Image size 2352x1568 — 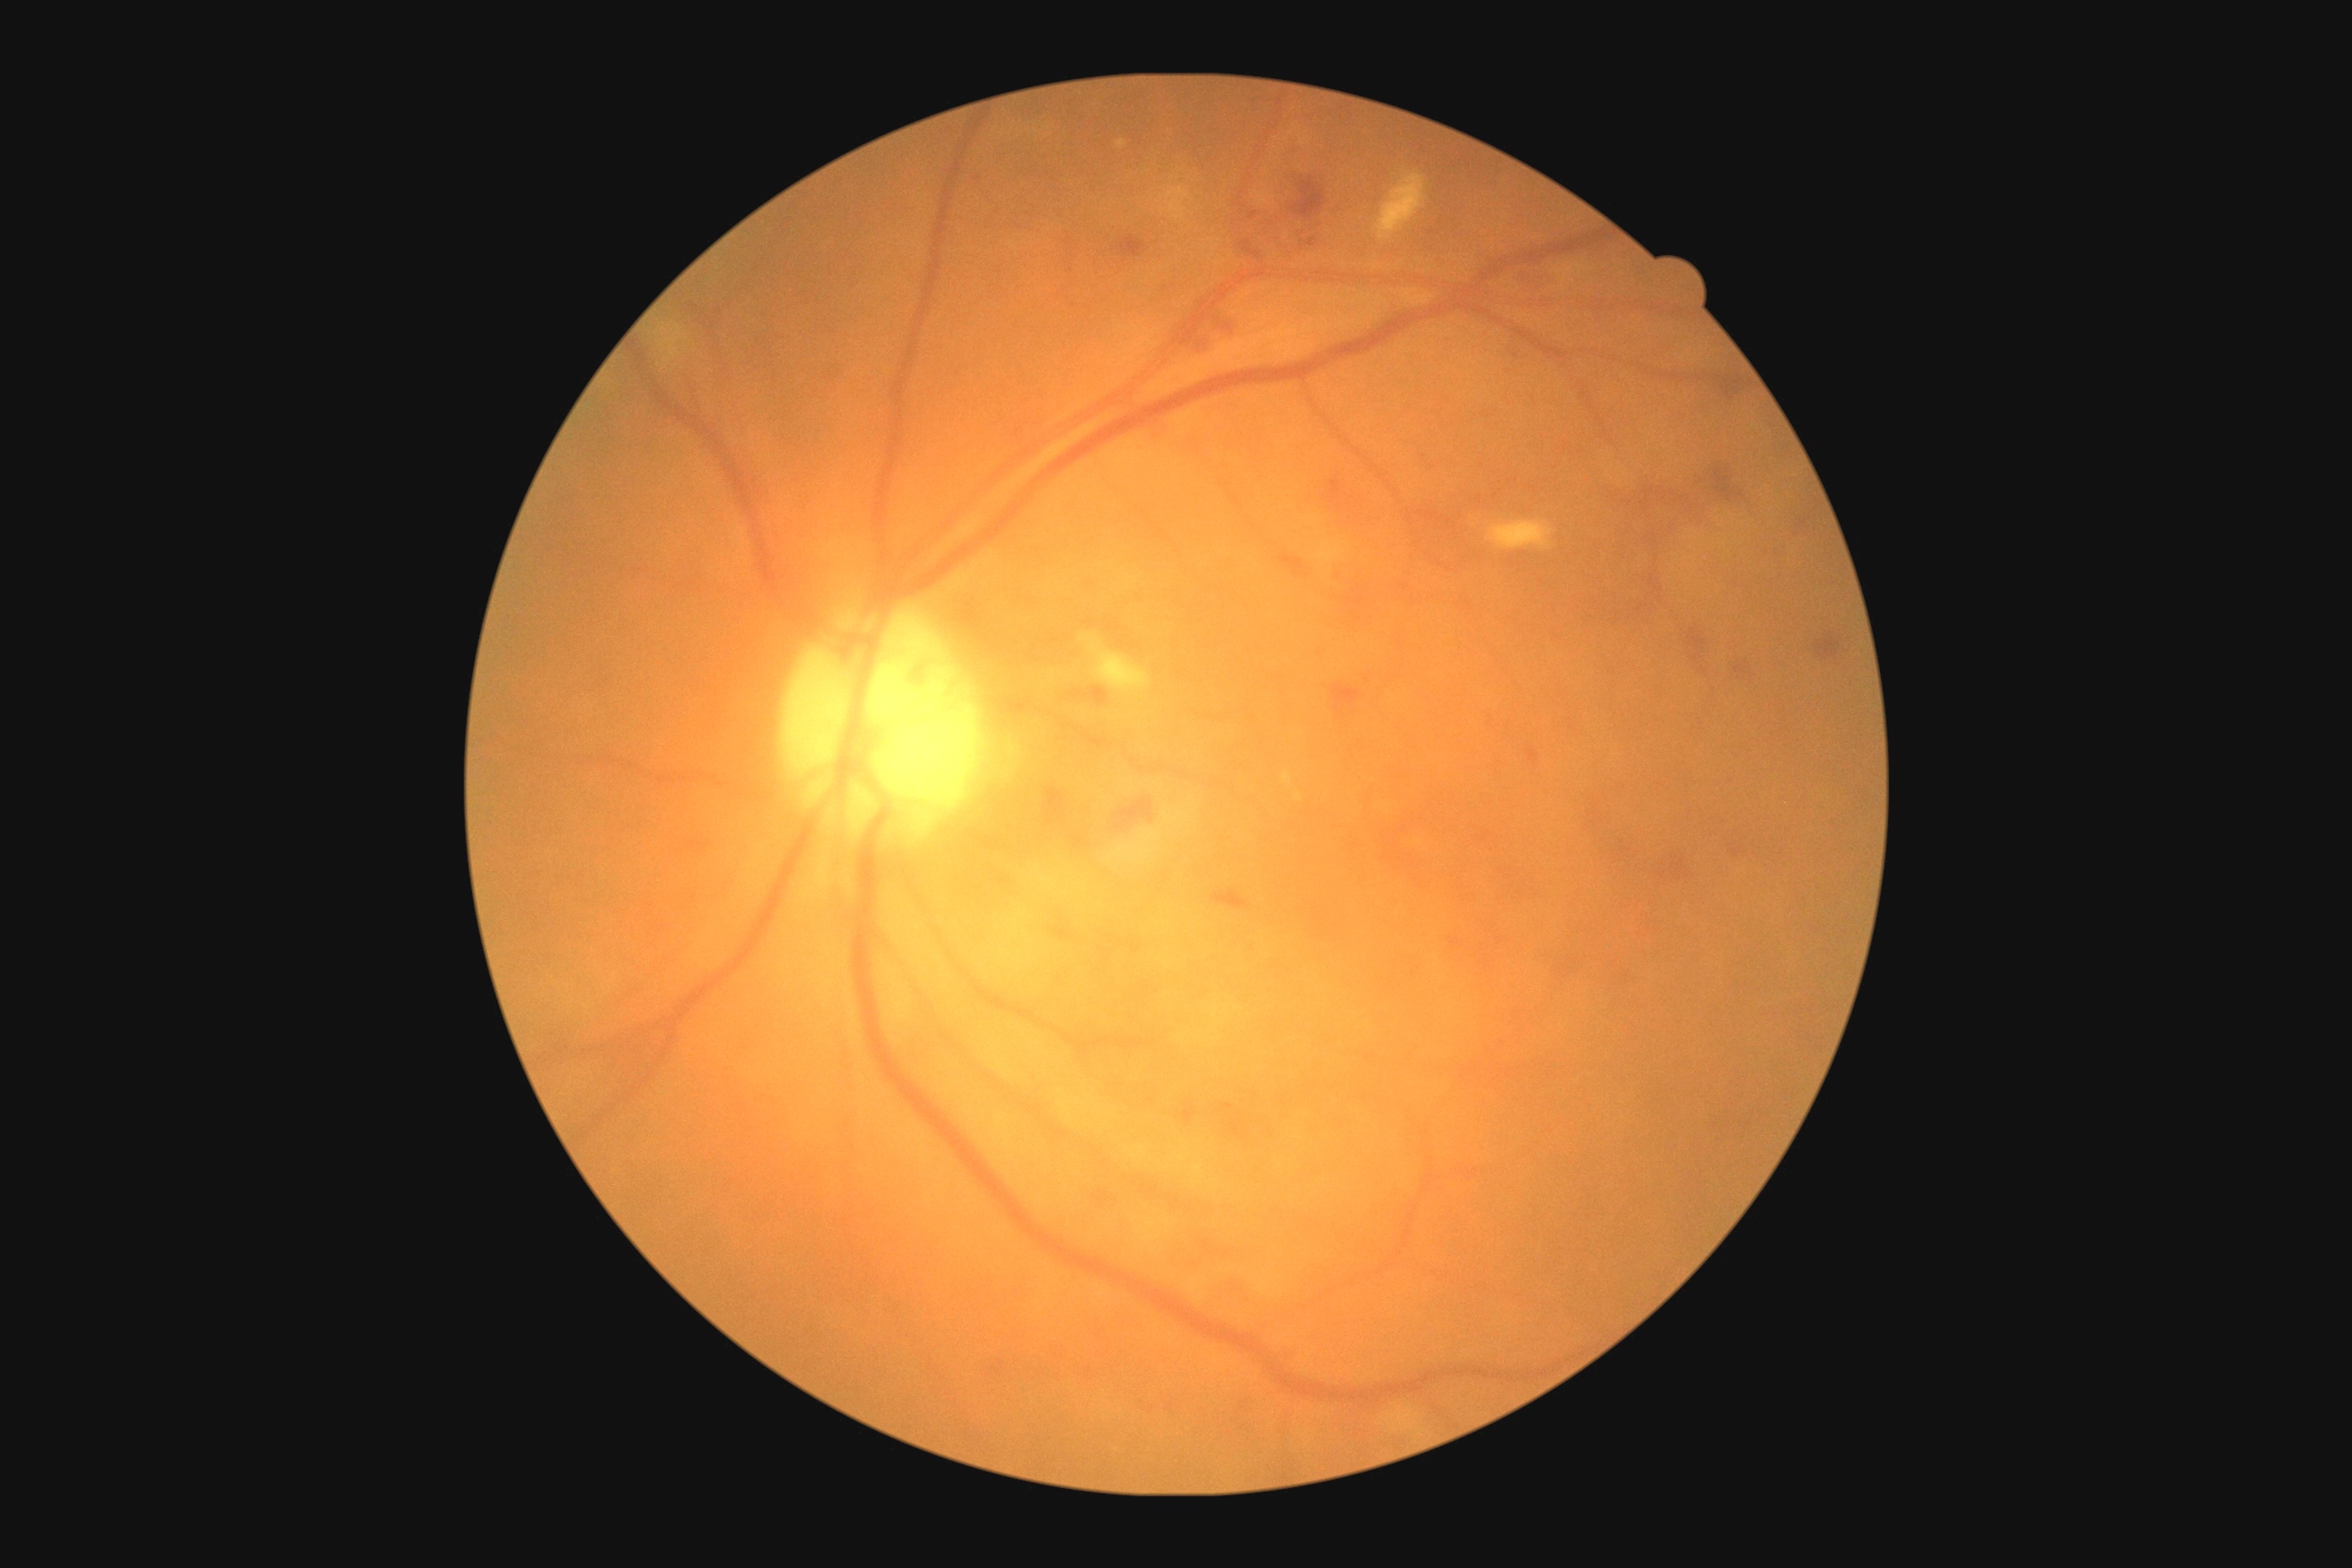
dr_grade: grade 2